2352x1568.
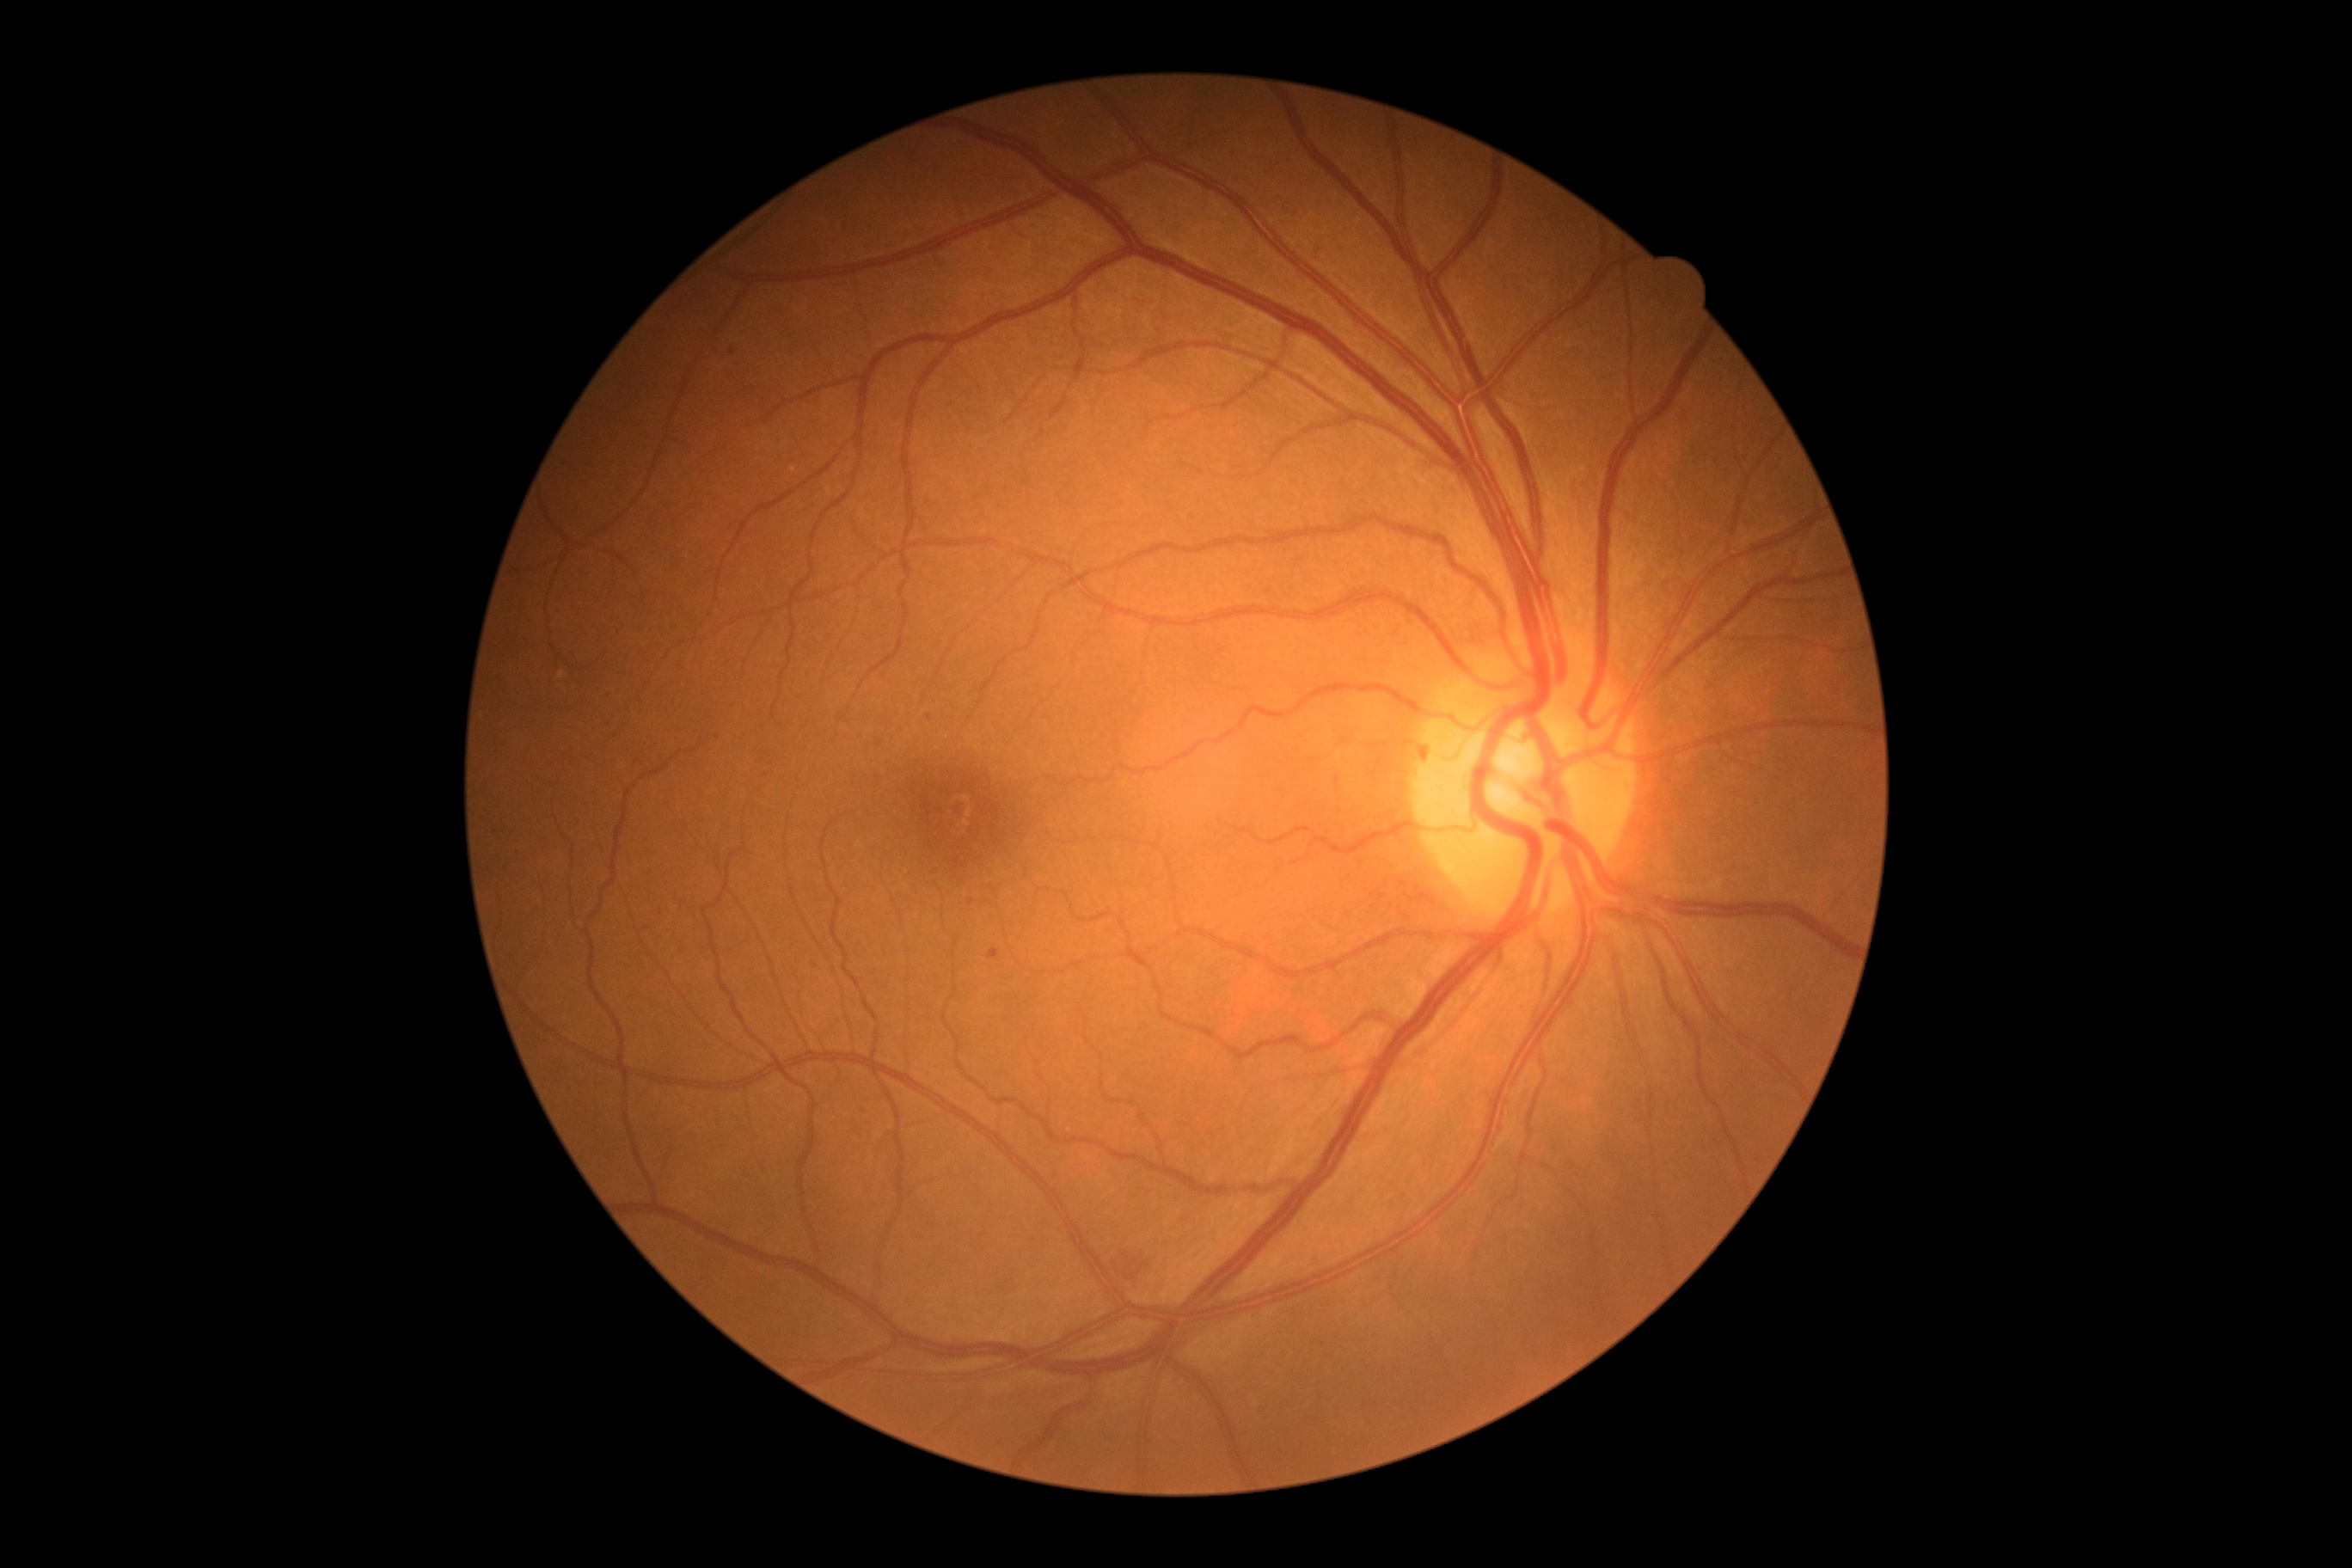

  dr_grade: 2 (moderate NPDR)